Modified Davis grading.
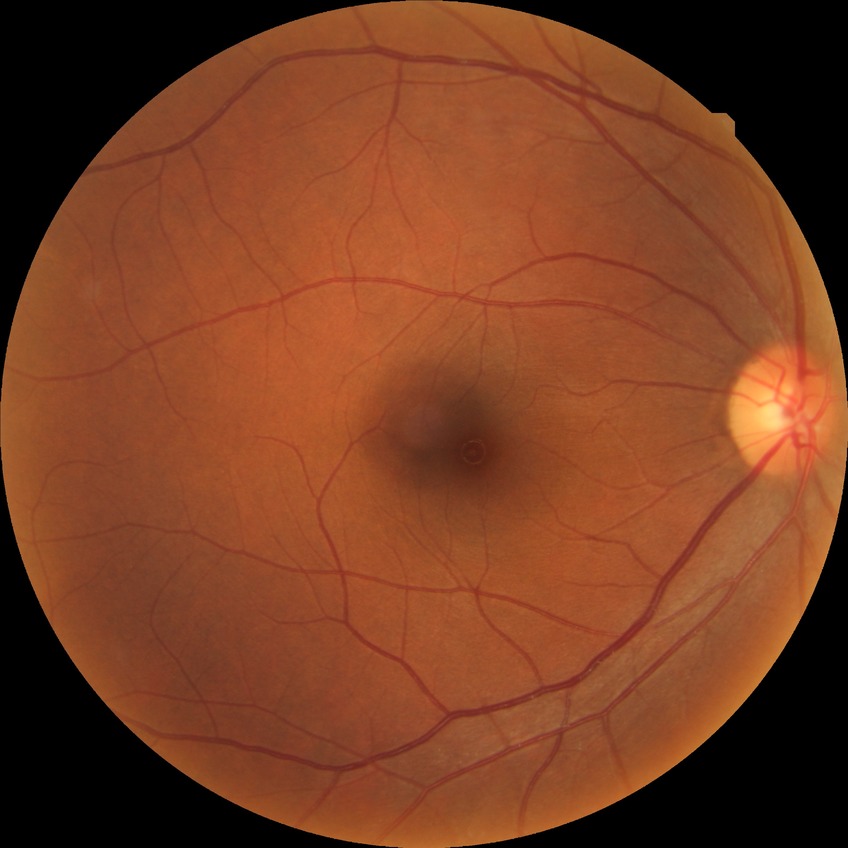

{"davis_grade": "no diabetic retinopathy (NDR)"}